45-degree field of view. CFP. 2352 by 1568 pixels:
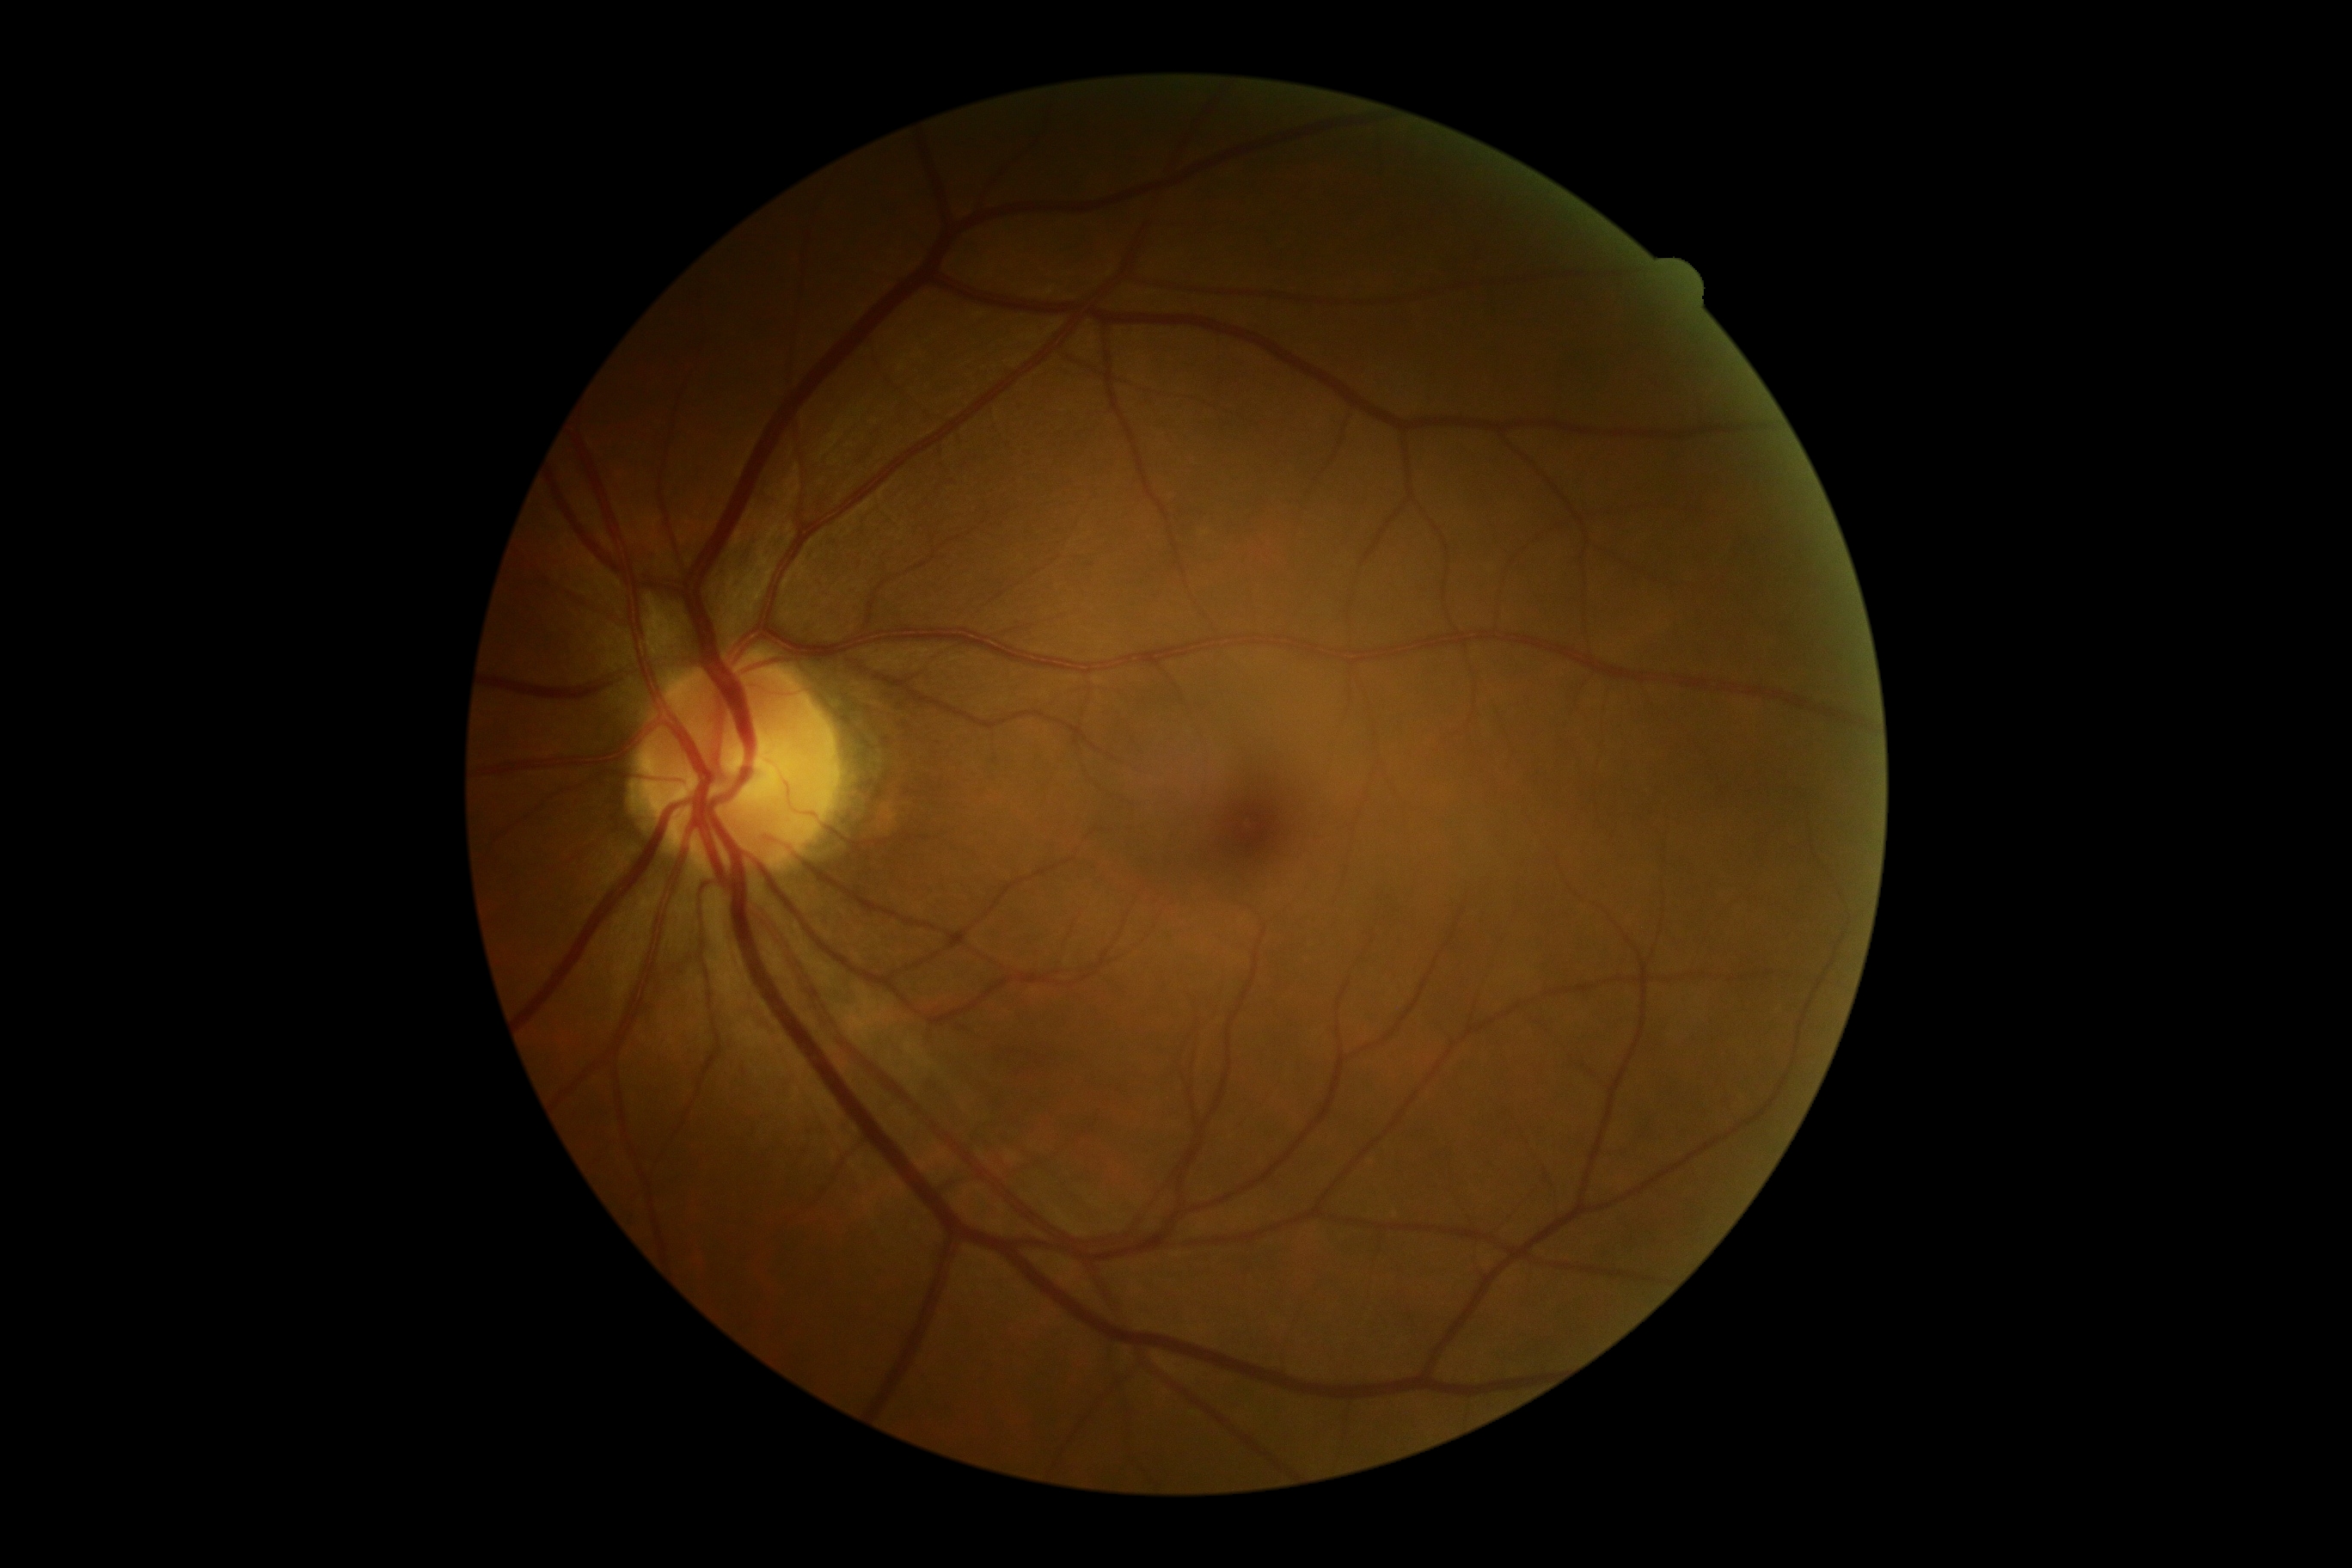 DR stage is 0.